Nonmydriatic.
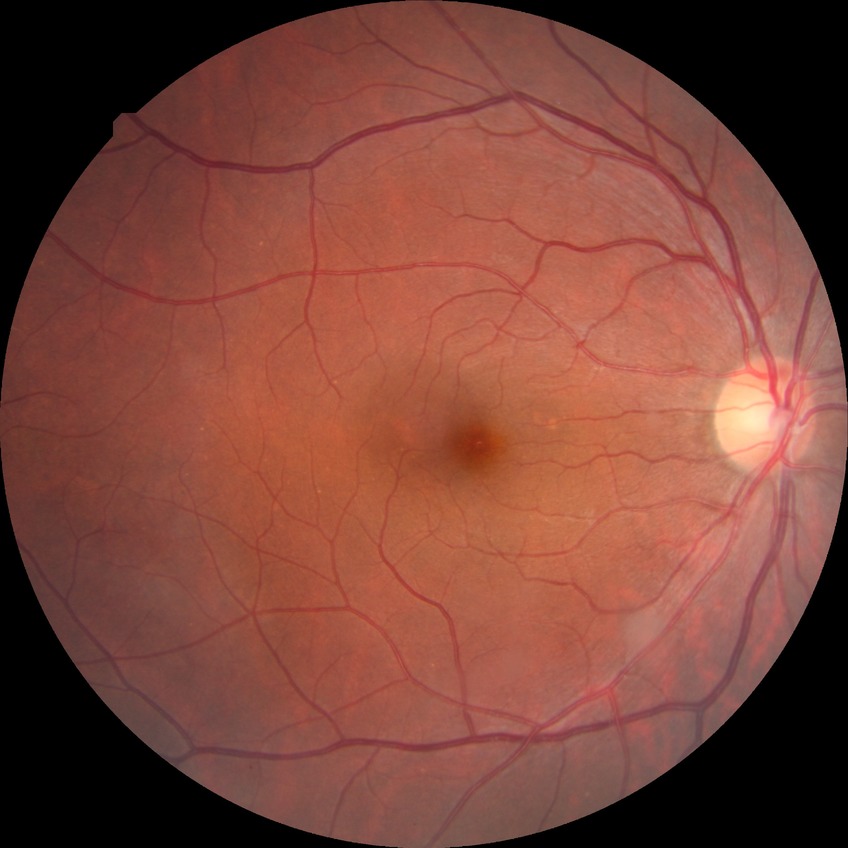 Diabetic retinopathy (DR): NDR (no diabetic retinopathy).